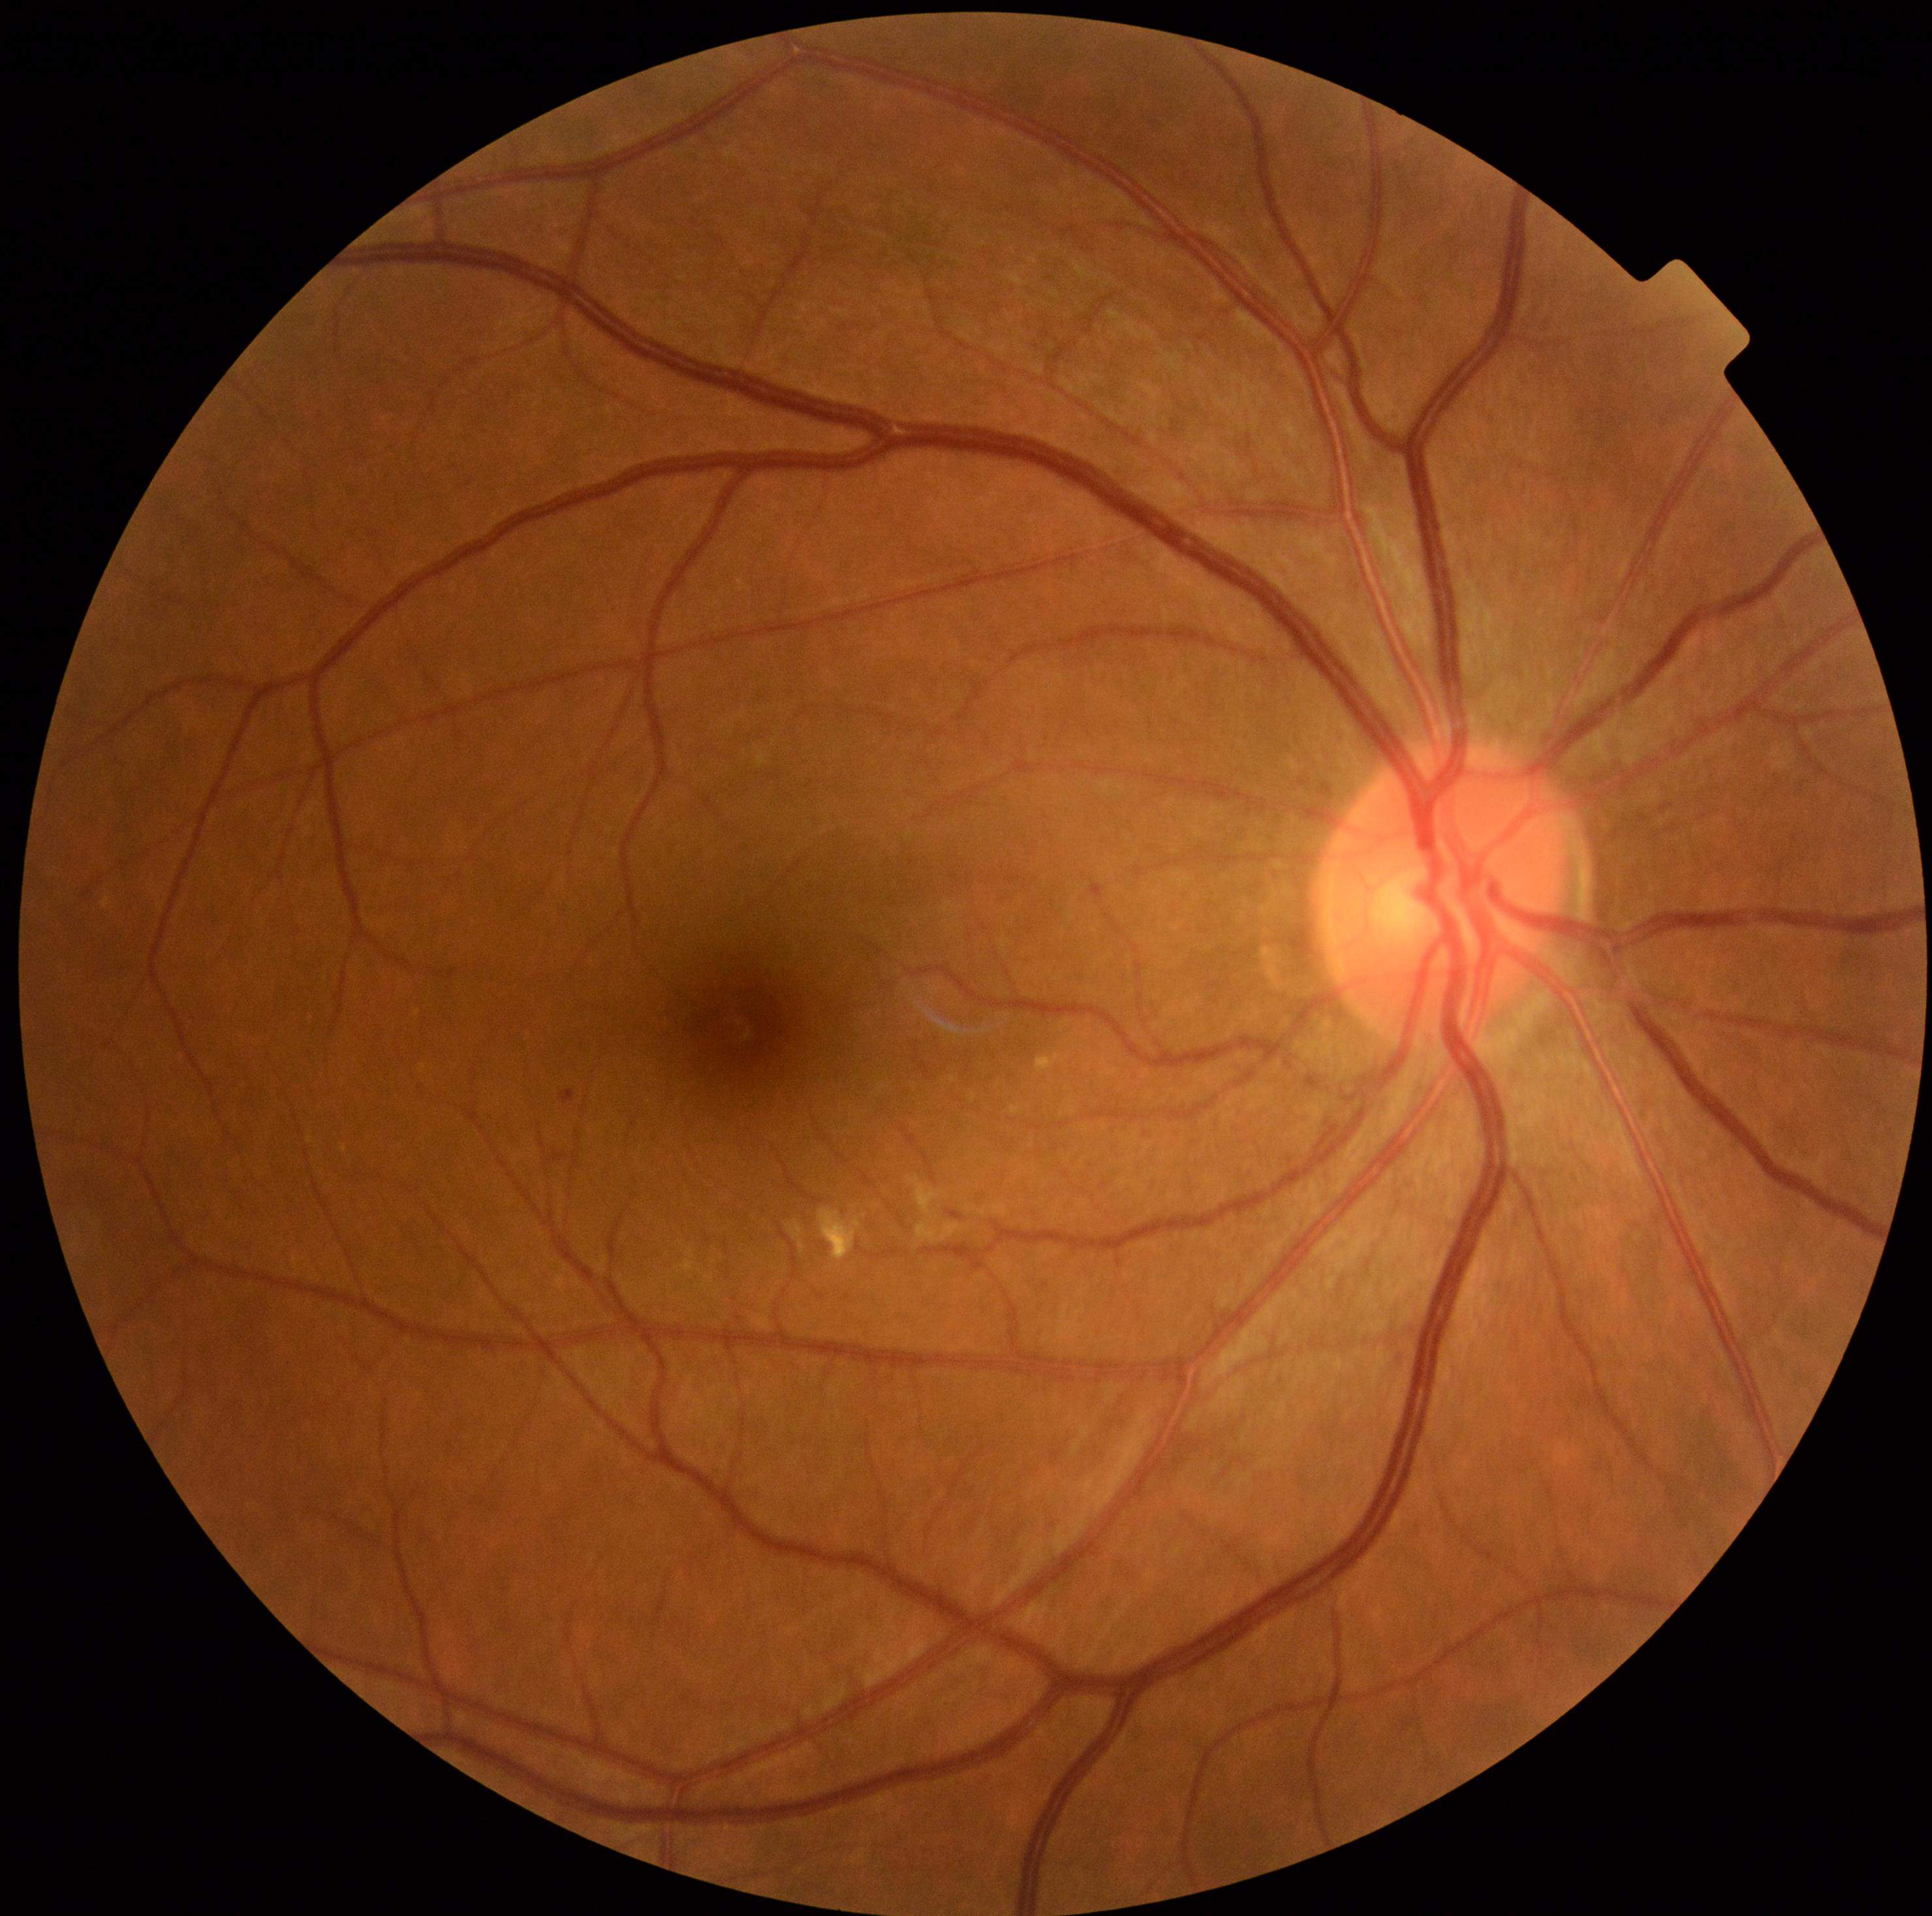

DR is 1 — presence of microaneurysms only.